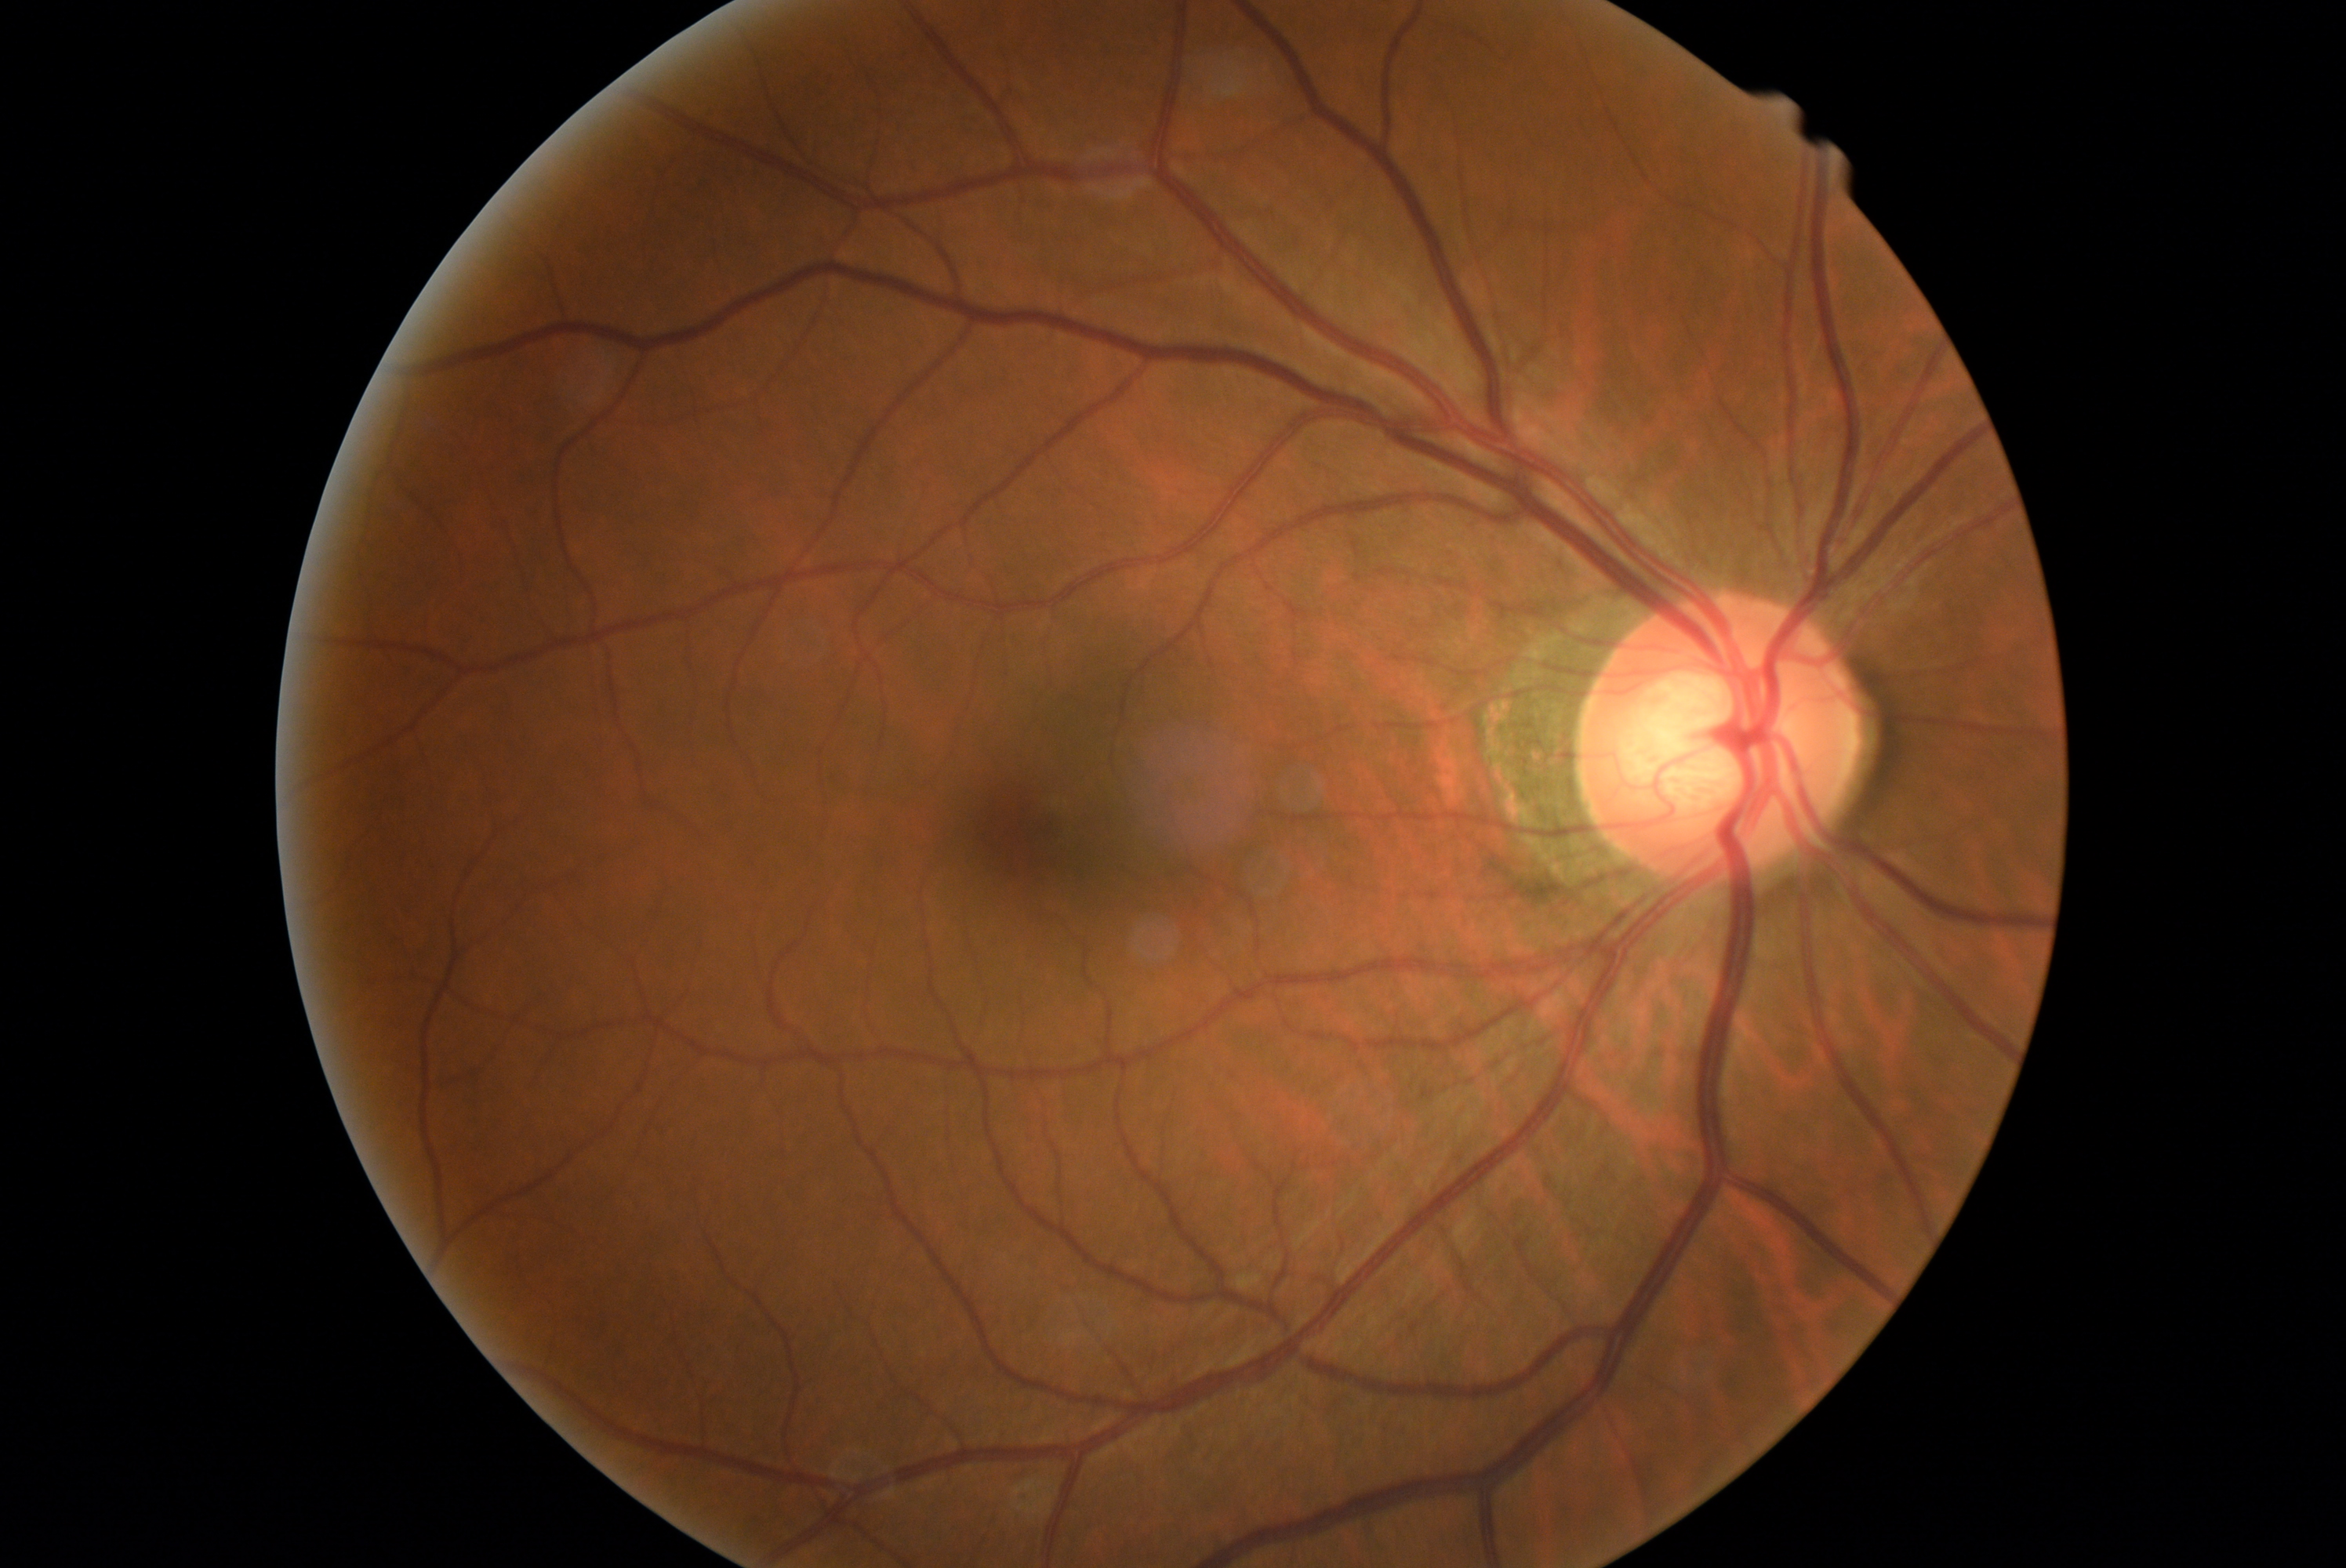

No signs of diabetic retinopathy. DR grade is no apparent diabetic retinopathy (0) — no visible signs of diabetic retinopathy.